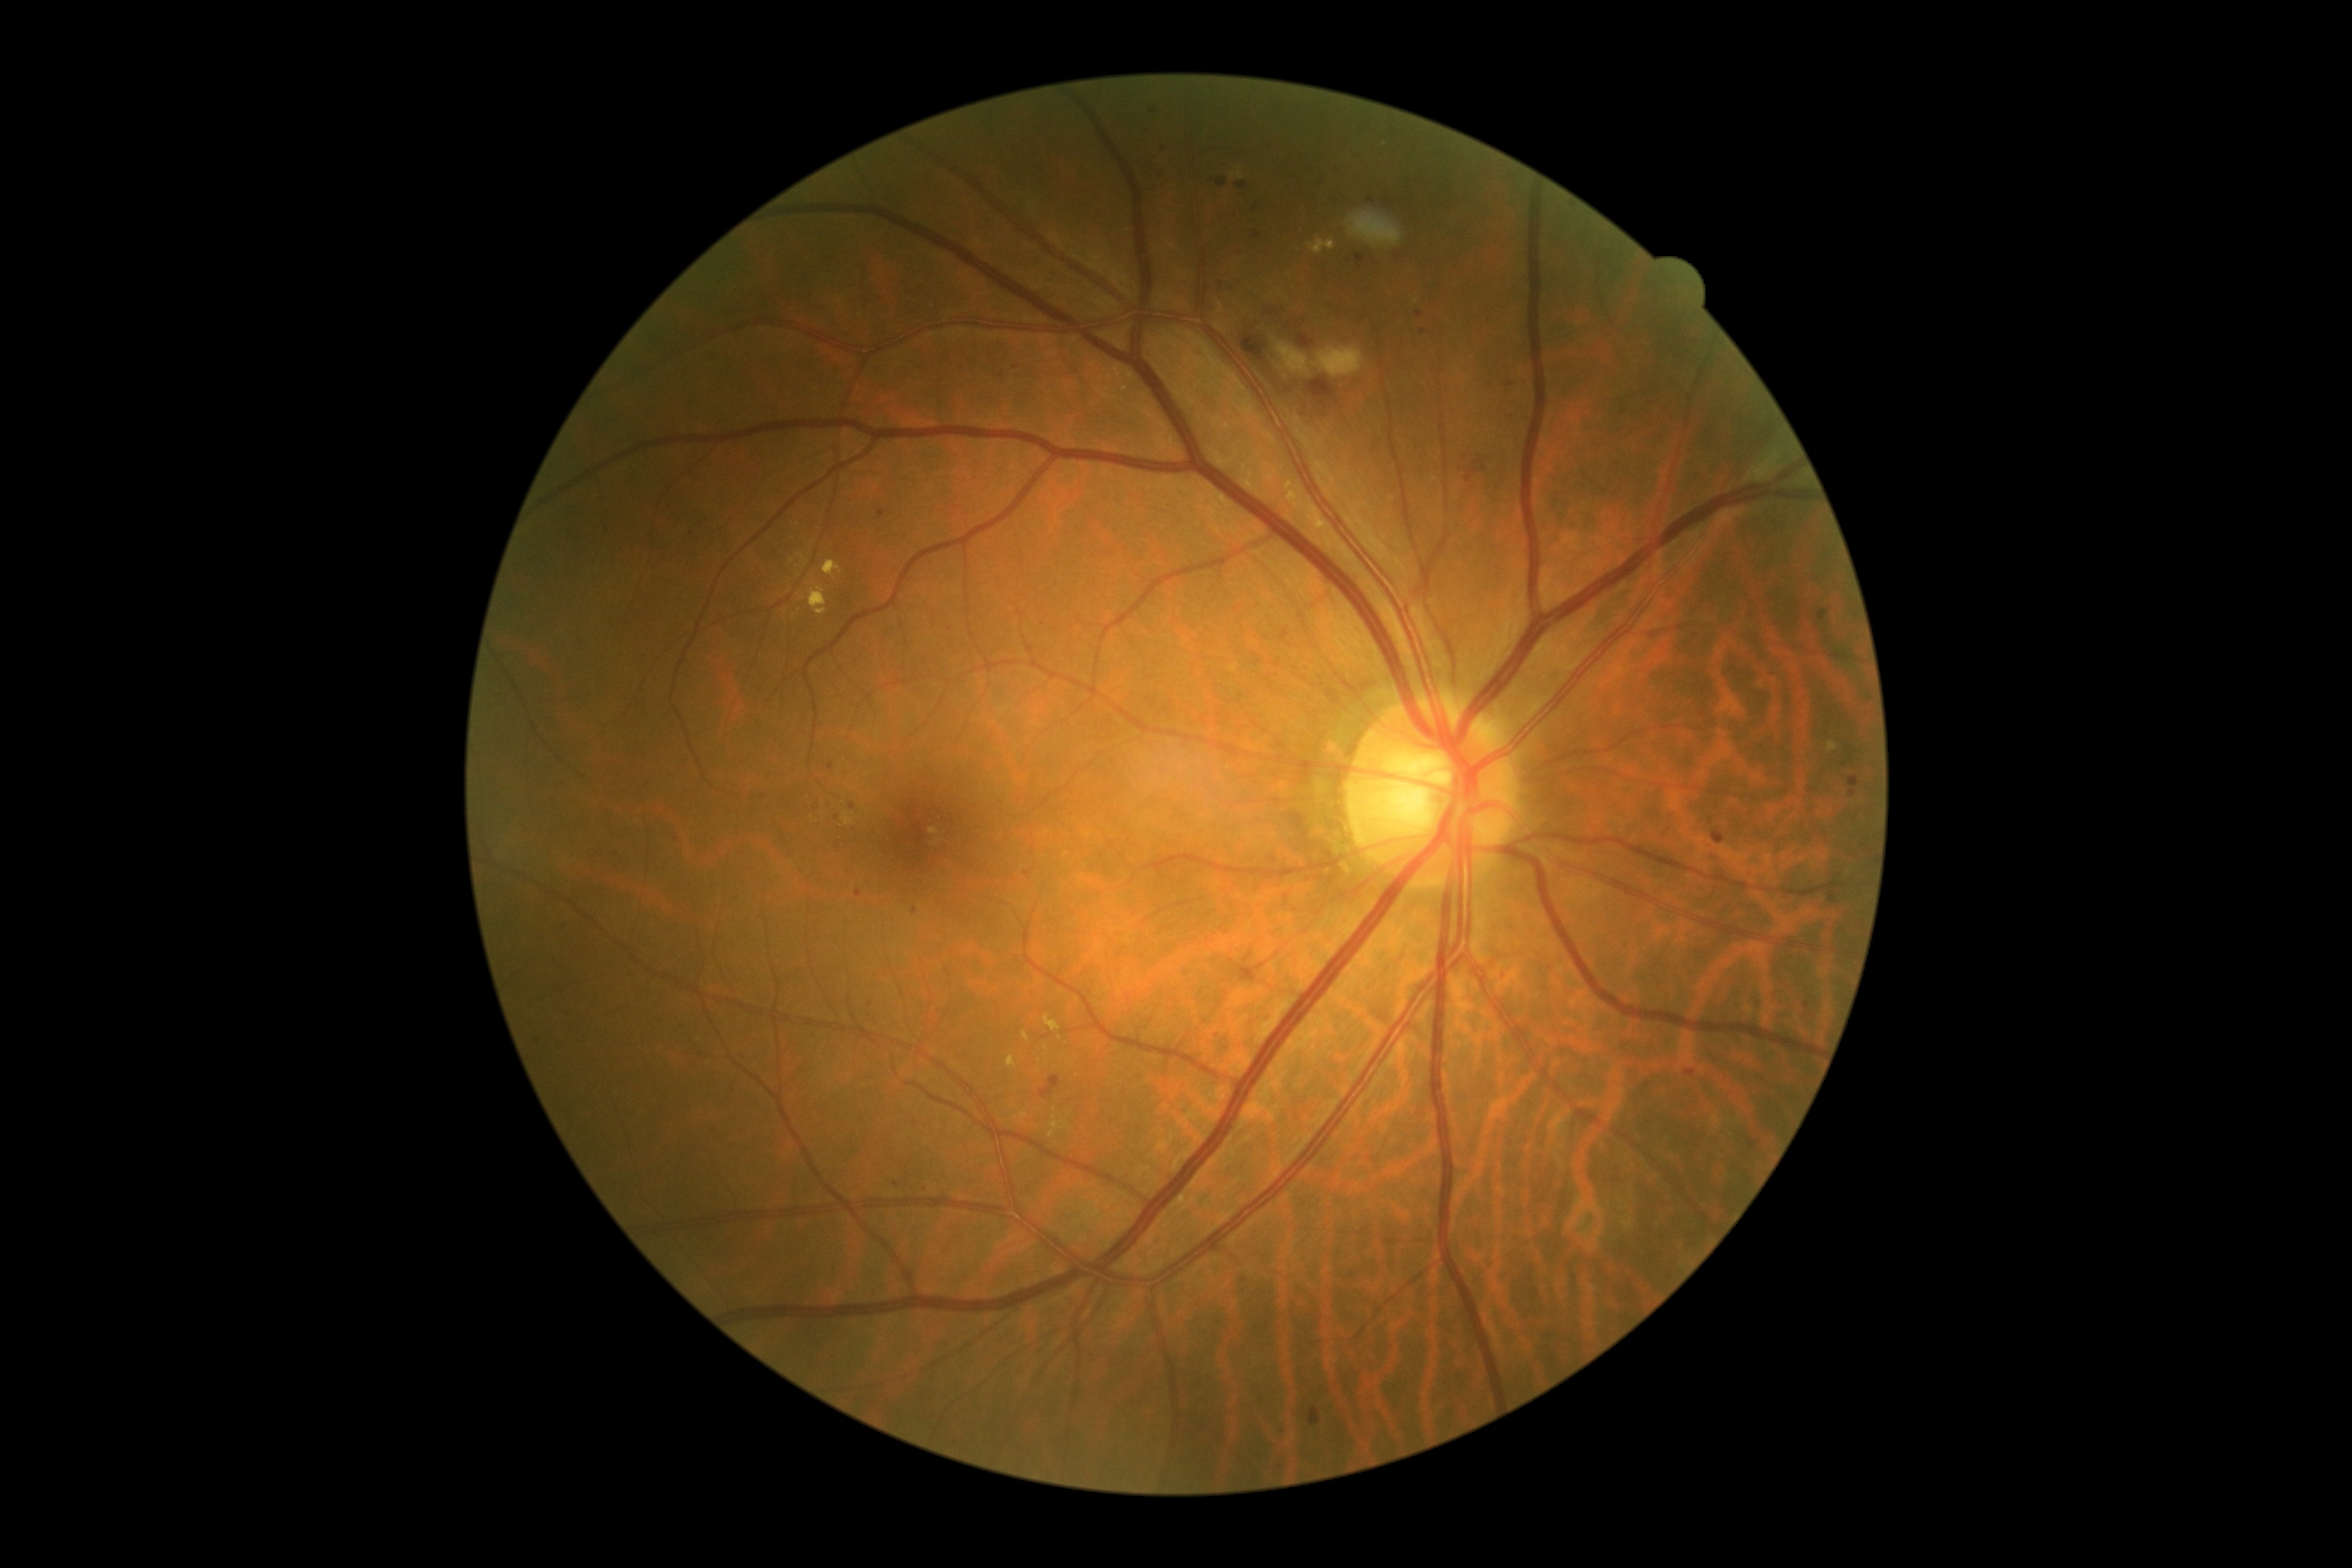

Retinopathy is grade 2 (moderate NPDR)
Selected lesions:
microaneurysms (more not shown): bbox=[1712, 831, 1725, 845] | bbox=[1849, 776, 1859, 787] | bbox=[1237, 181, 1249, 190] | bbox=[1253, 231, 1261, 240] | bbox=[1320, 178, 1326, 187] | bbox=[1332, 195, 1338, 211] | bbox=[1356, 254, 1364, 267] | bbox=[1039, 1075, 1060, 1098] | bbox=[912, 907, 917, 916] | bbox=[878, 510, 885, 520]
Additional small microaneurysms near 1027:876 | 837:818 | 1015:368 | 1287:896 | 618:855 | 1152:111 | 871:1005 | 1419:314 | 1510:386 | 1624:412
hard exudates (more not shown): bbox=[1048, 1115, 1065, 1137] | bbox=[1244, 481, 1254, 491] | bbox=[1024, 1031, 1031, 1043] | bbox=[1044, 1015, 1060, 1032] | bbox=[809, 582, 826, 616] | bbox=[1020, 1112, 1029, 1118]
Additional small hard exudates near 1017:1118 | 1251:475 | 1055:1110 | 802:557 | 1232:176 | 791:562